Color fundus image: 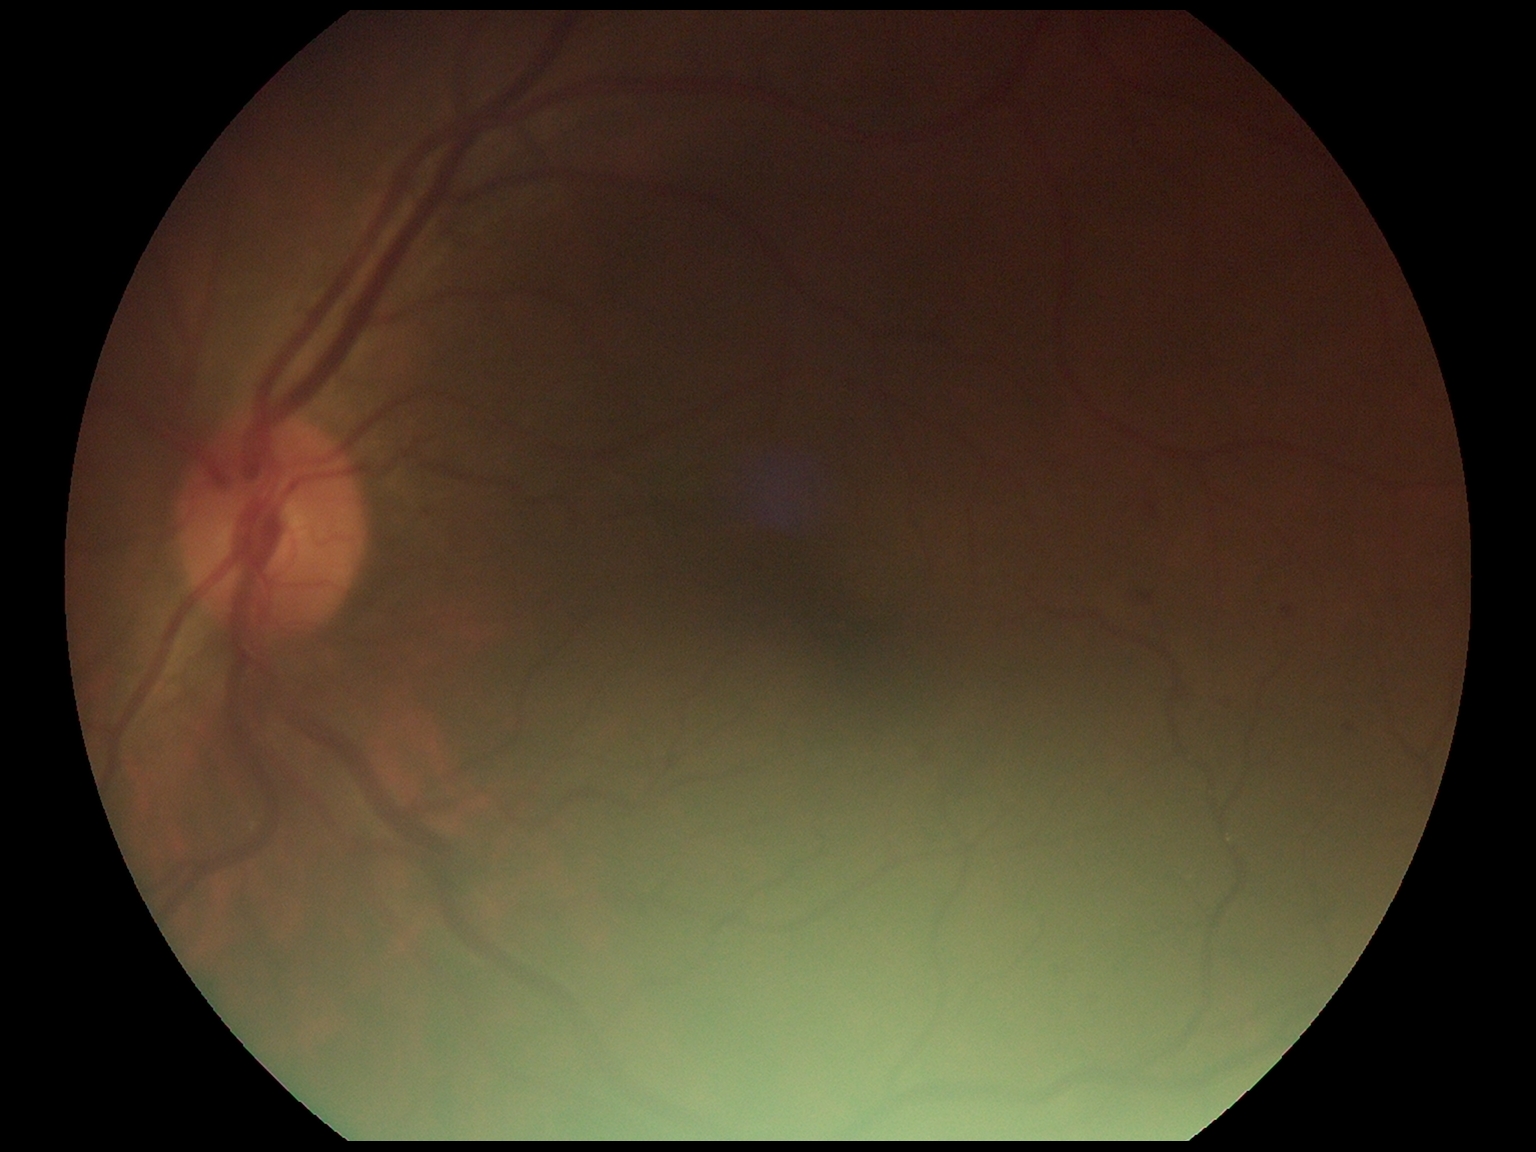

Retinopathy: 2.